45° field of view
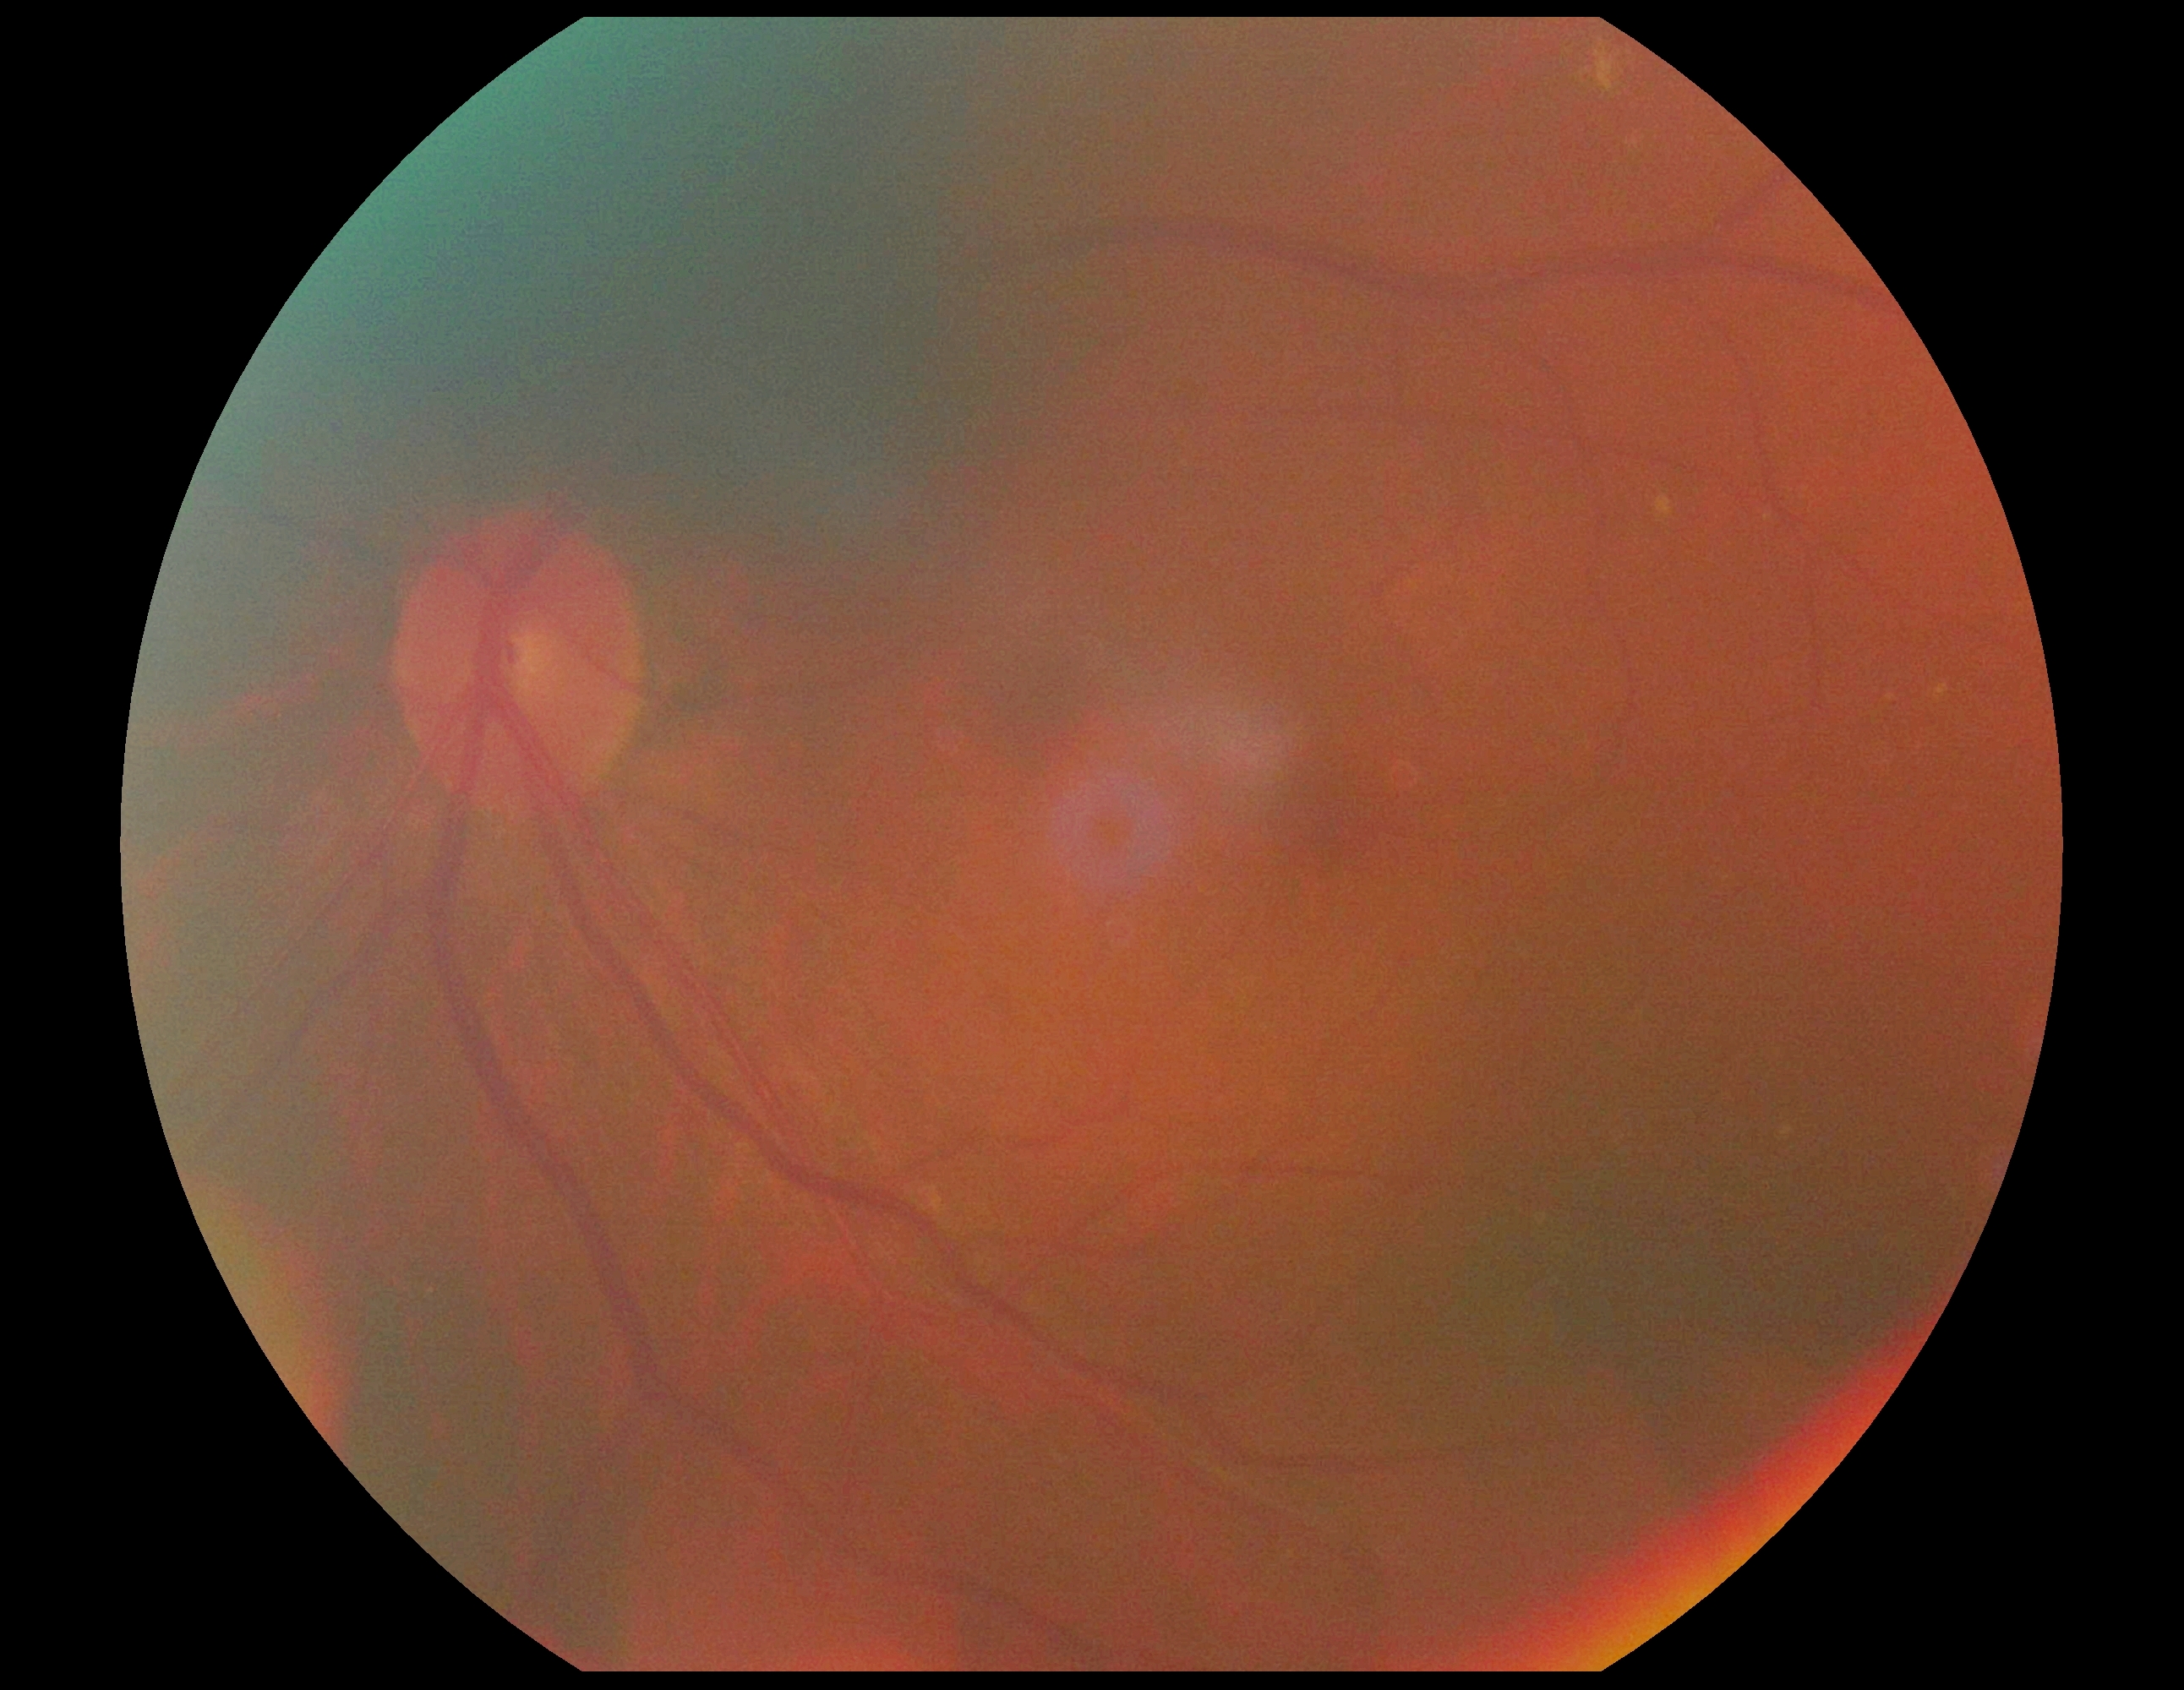

dr_grade: 0/4
dr_impression: negative for DR